Color fundus photograph · 848 by 848 pixels
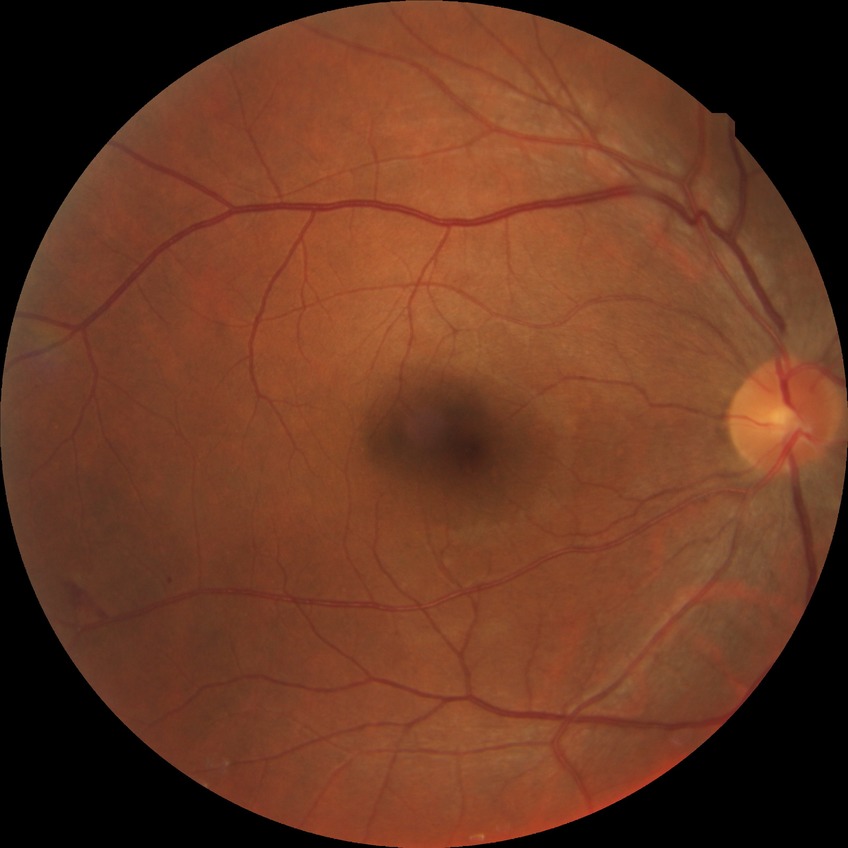

Modified Davis grade: SDR.